1240 x 1240 pixels; wide-field fundus image from infant ROP screening — 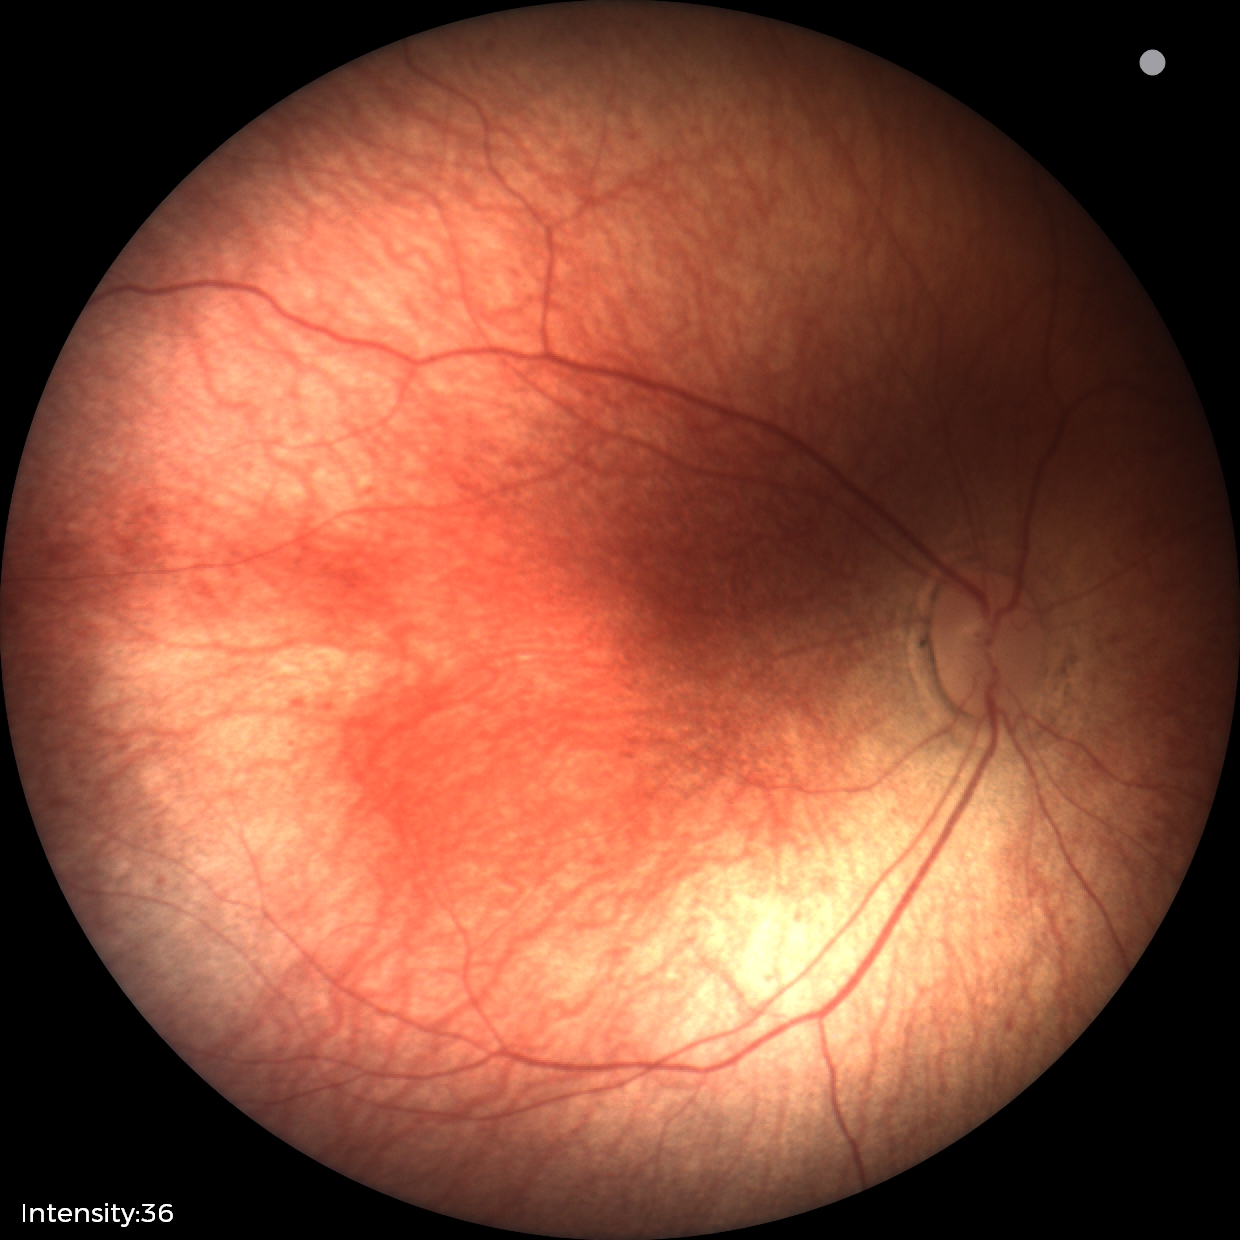
Physiological retinal appearance for postconceptual age.